Fundus photo.
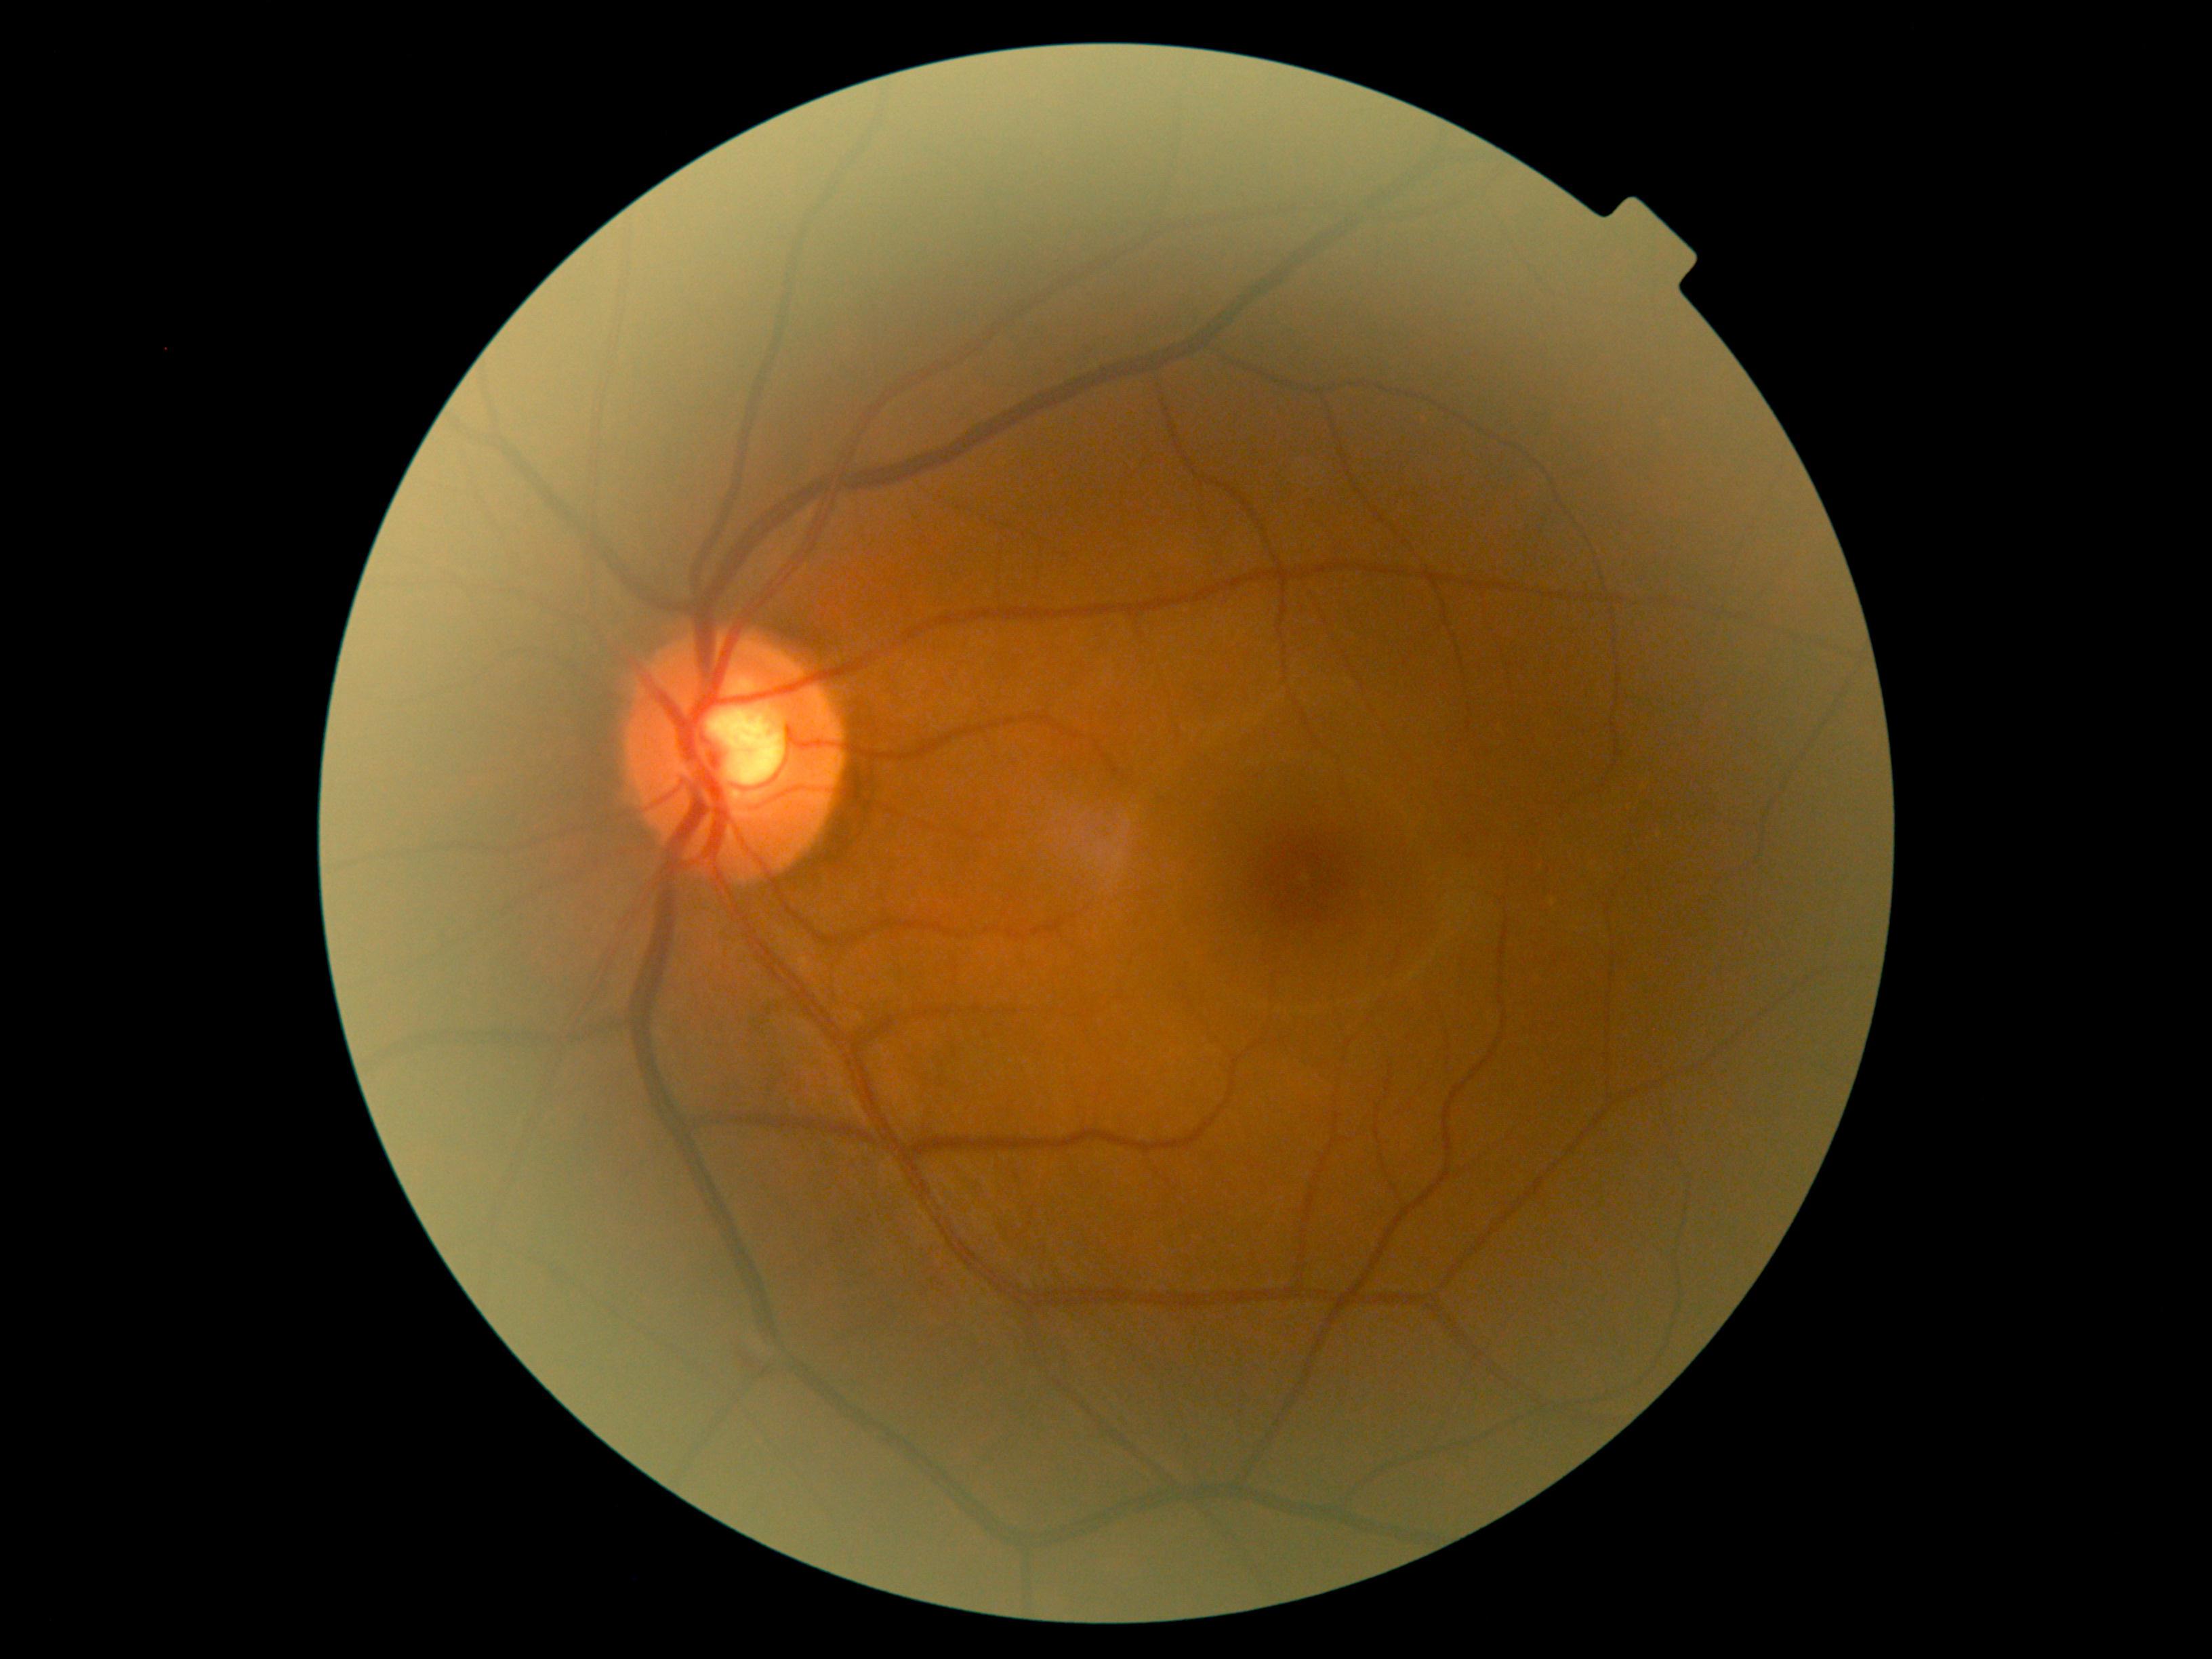 DR: 0/4.